Portable fundus camera image.
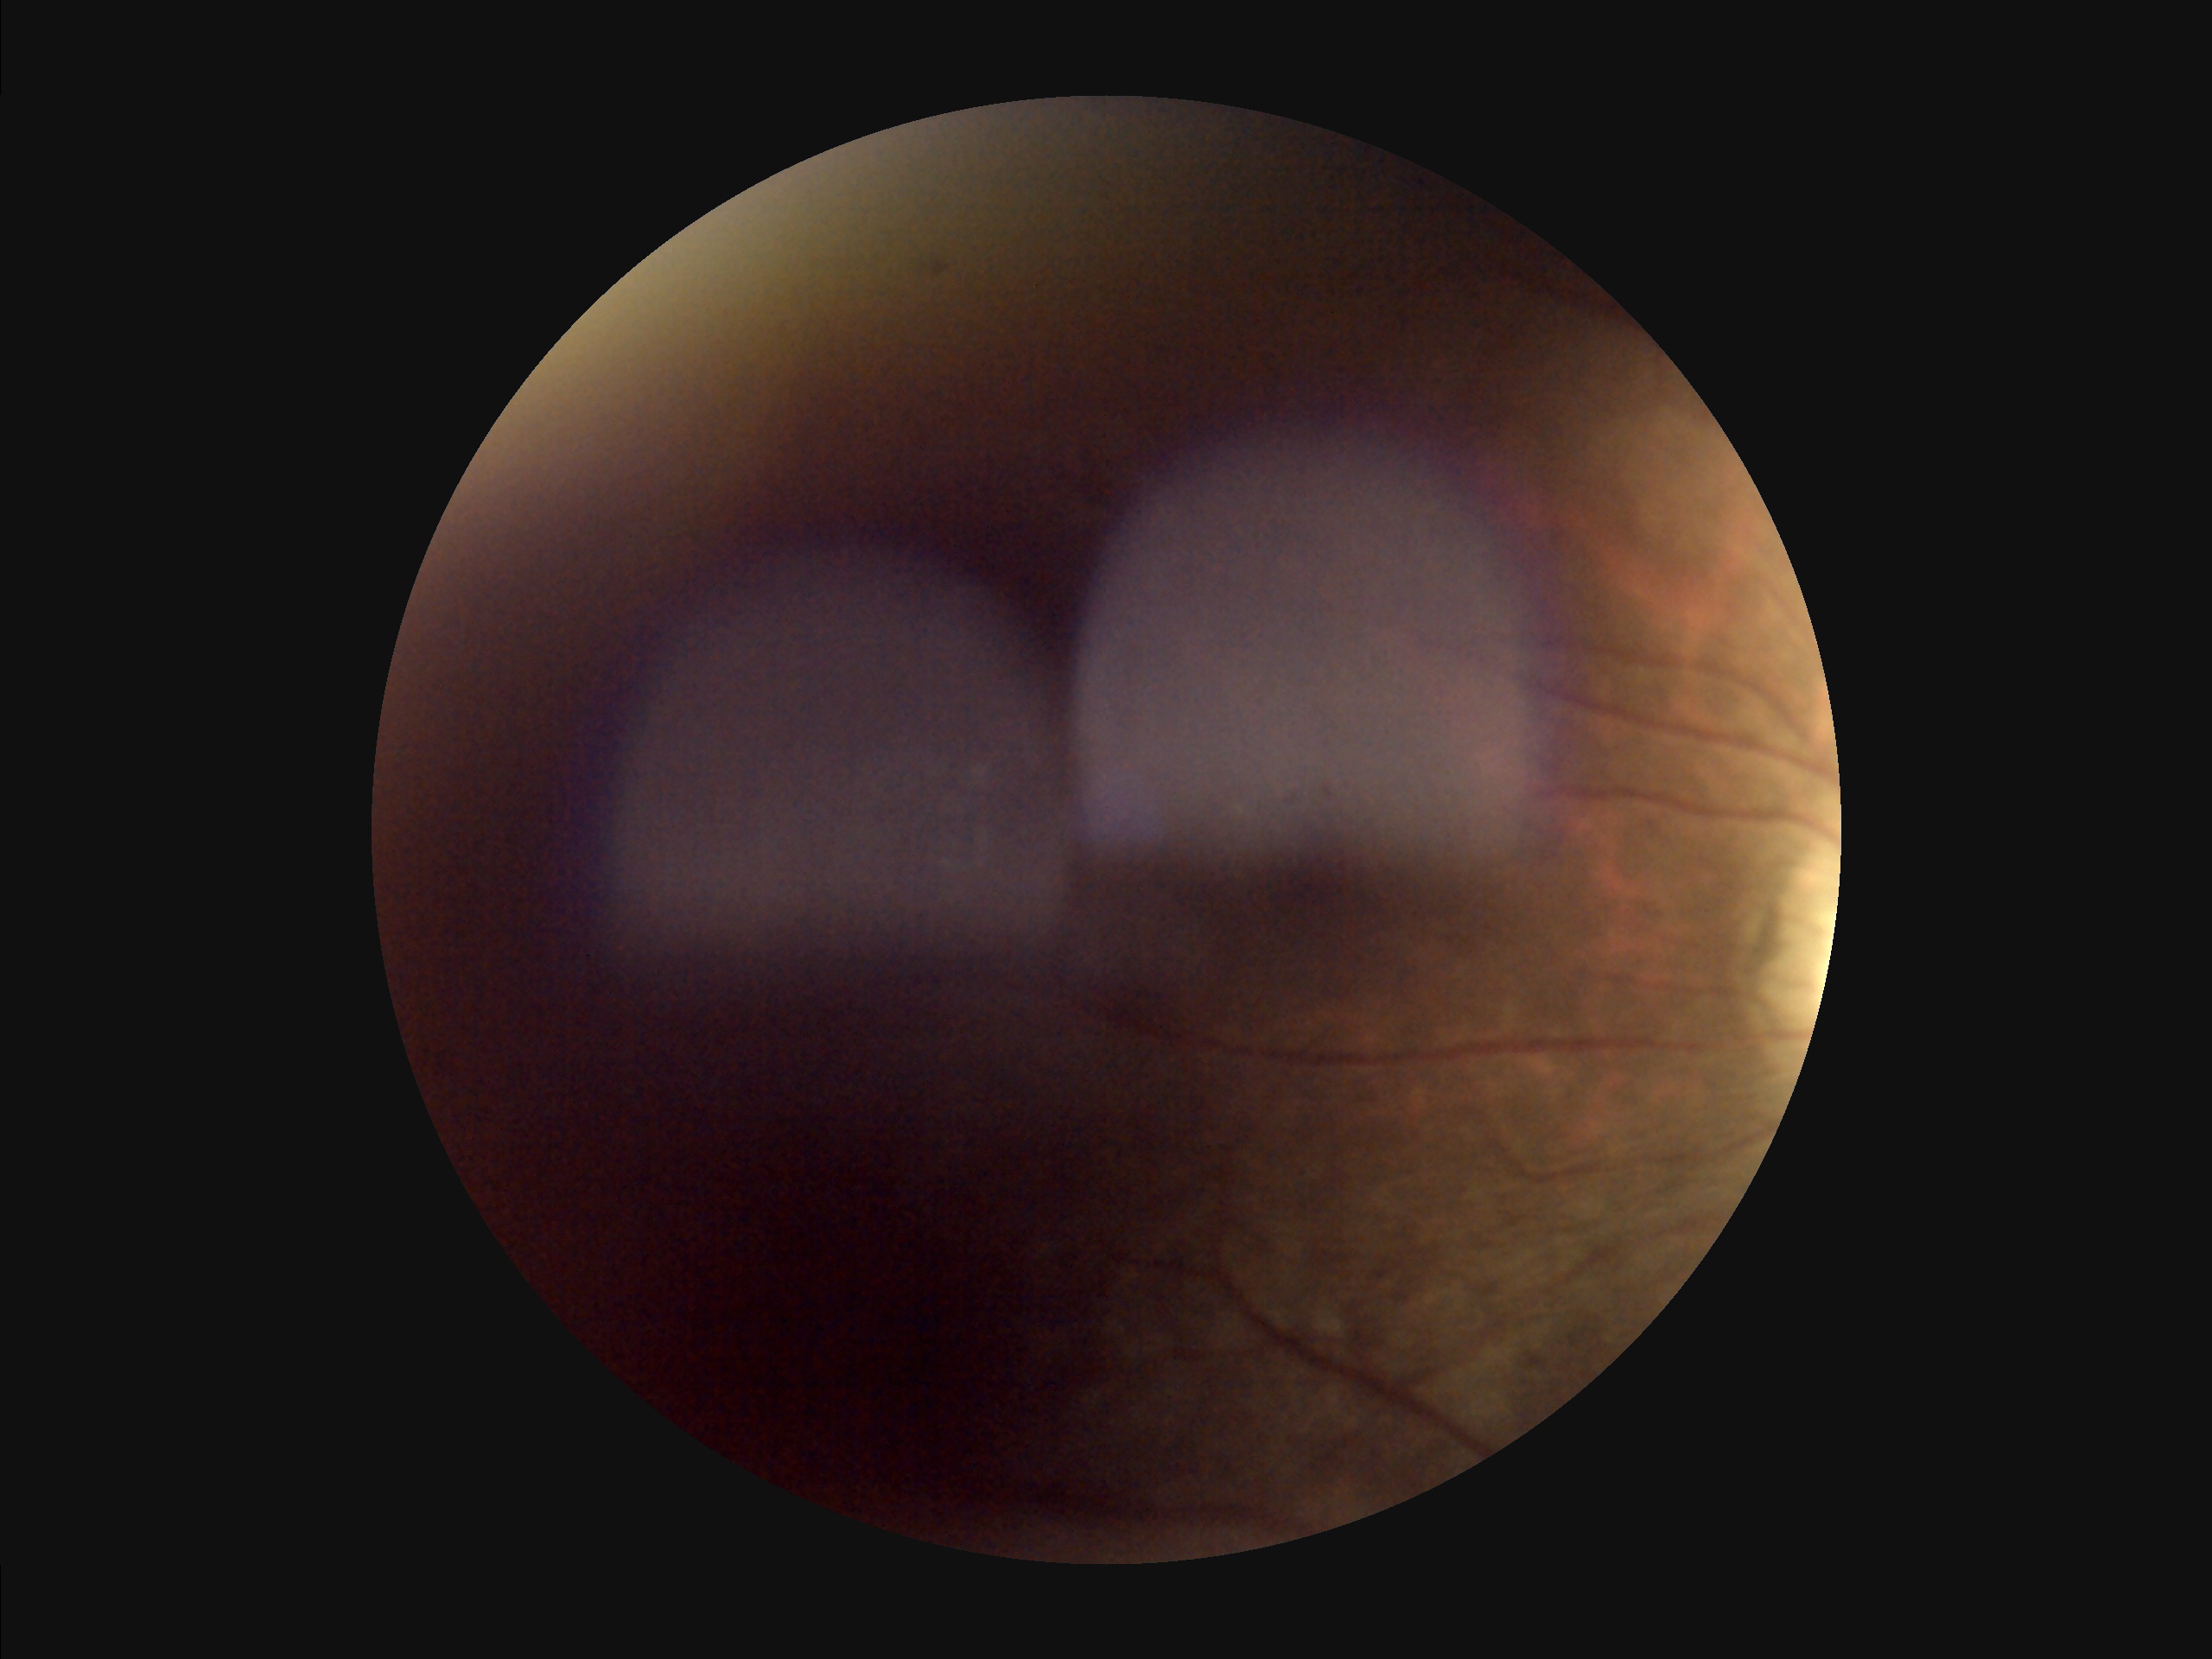

Image quality assessment: illumination/color: inadequate, with uneven exposure or color distortion | contrast: narrow intensity range, structures hard to distinguish | focus: noticeable blur in the optic disc, vessels, or background | overall: inadequate for clinical interpretation.